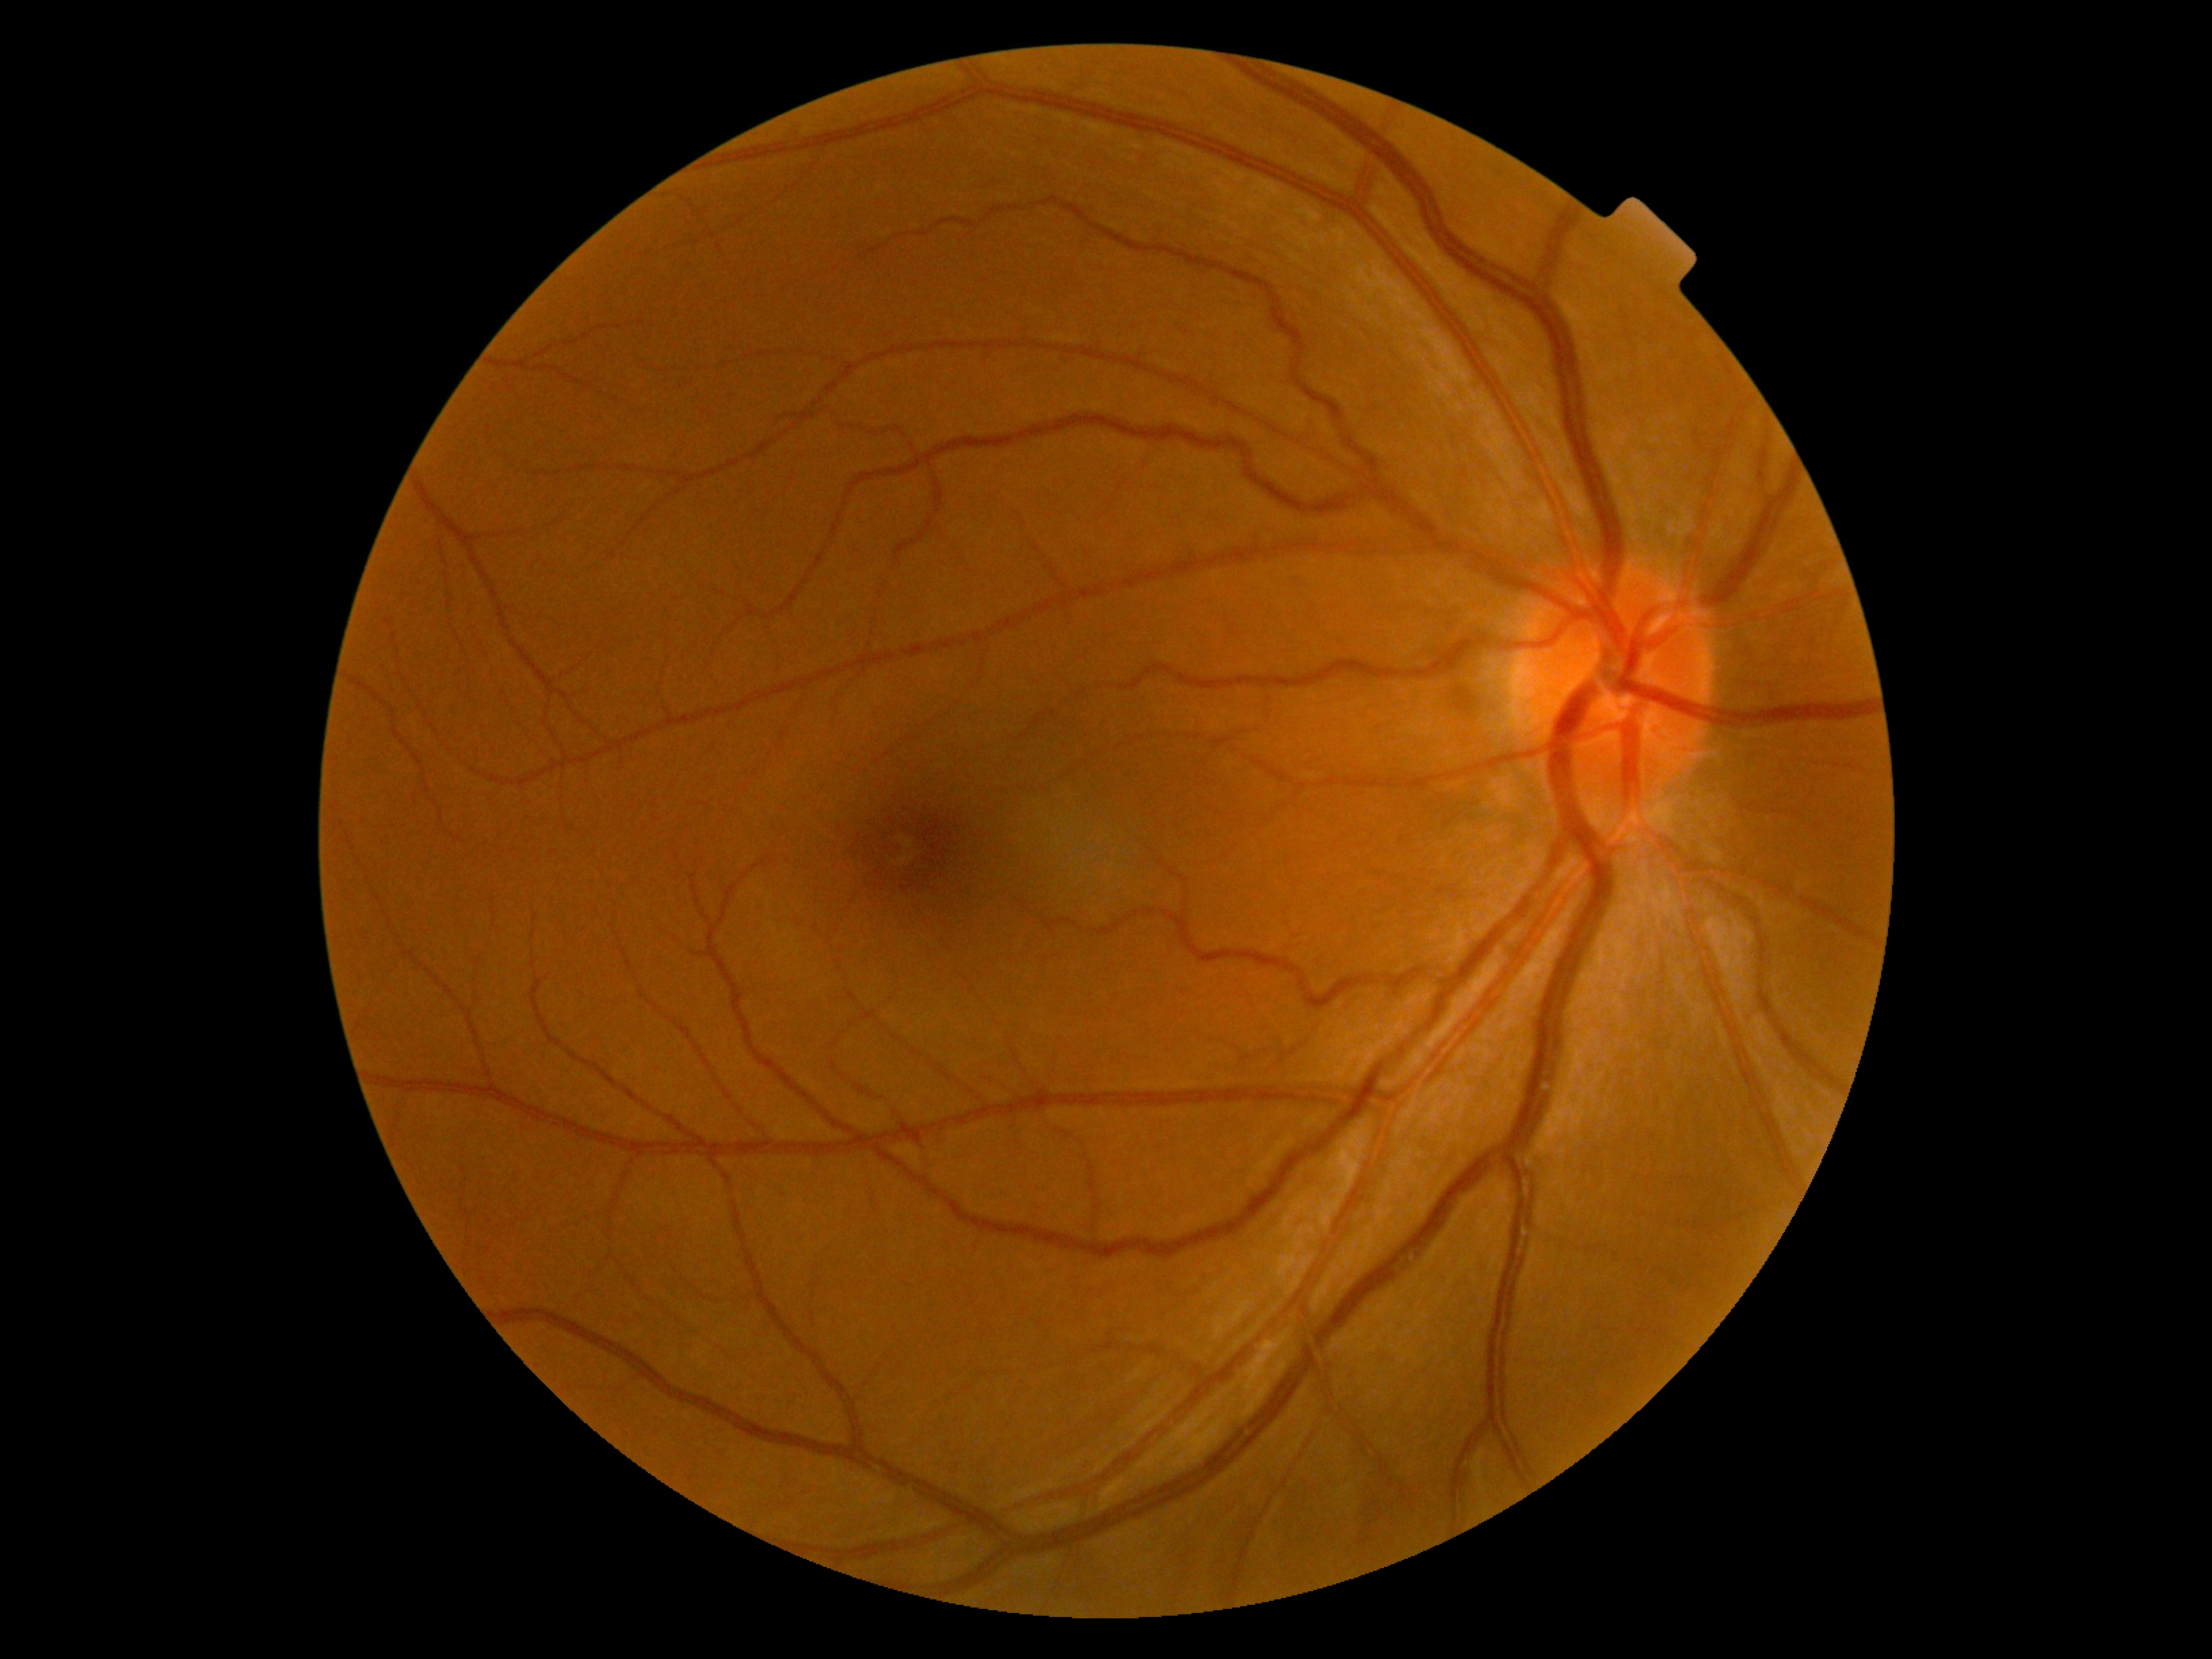
No signs of diabetic retinopathy. Diabetic retinopathy grade is 0 (no apparent retinopathy).